848 x 848 pixels · DR severity per modified Davis staging — 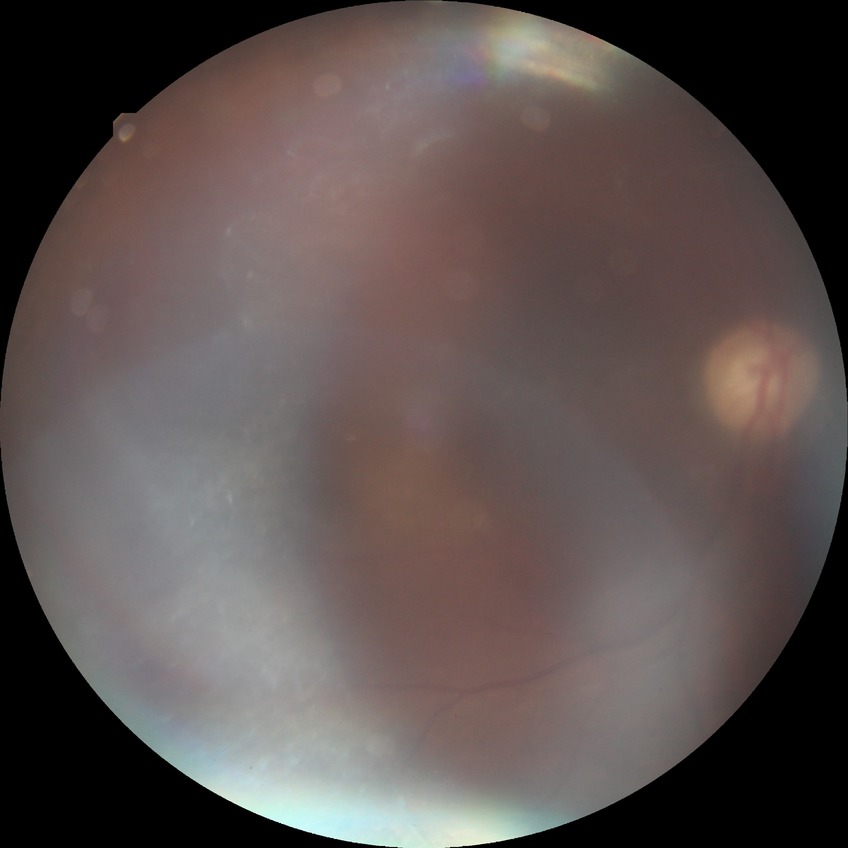 Diabetic retinopathy (DR): PDR (proliferative diabetic retinopathy).